Wide-field fundus photograph of an infant: 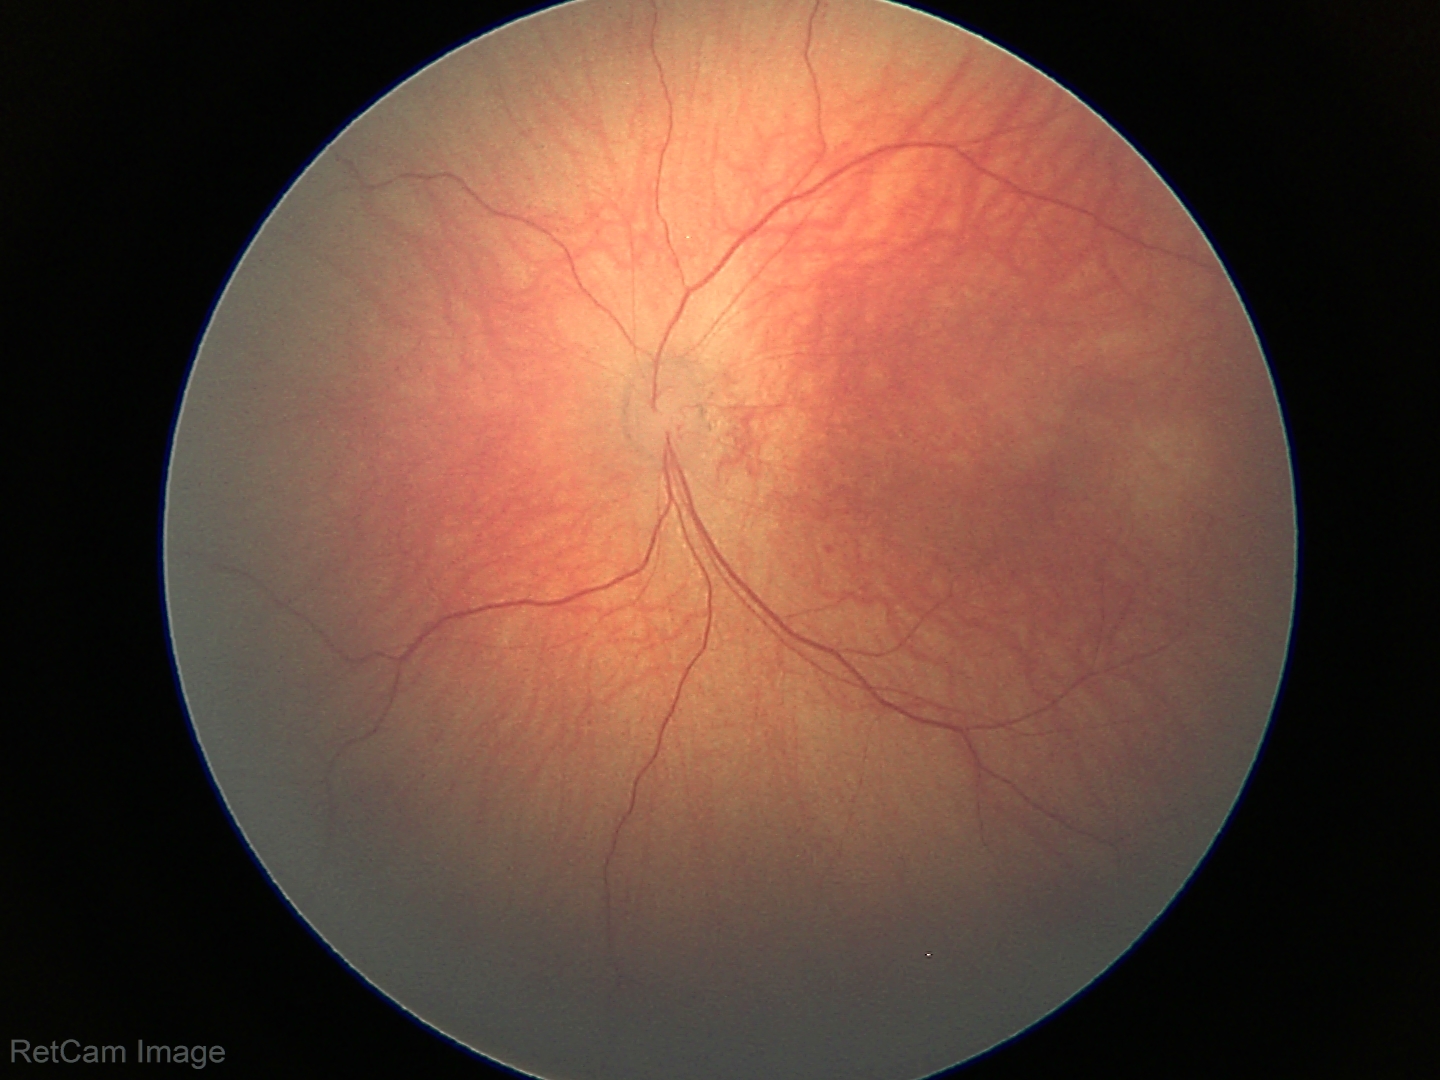

Normal screening examination.